640 by 480 pixels · pediatric wide-field fundus photograph.
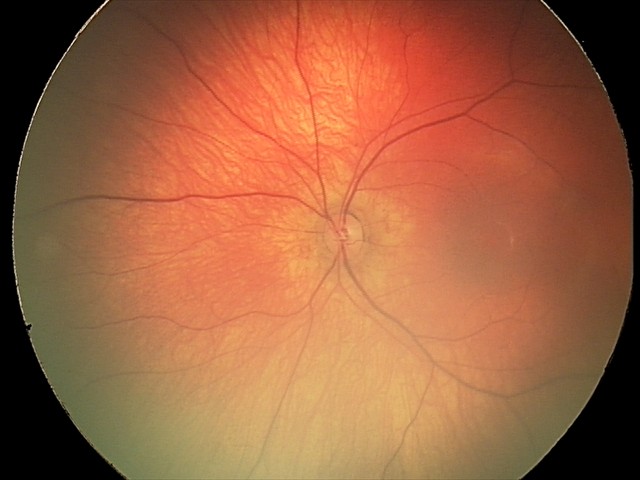
Normal screening examination.